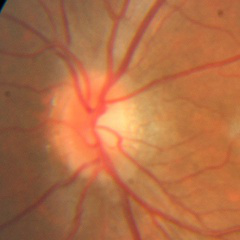
No signs of glaucoma.